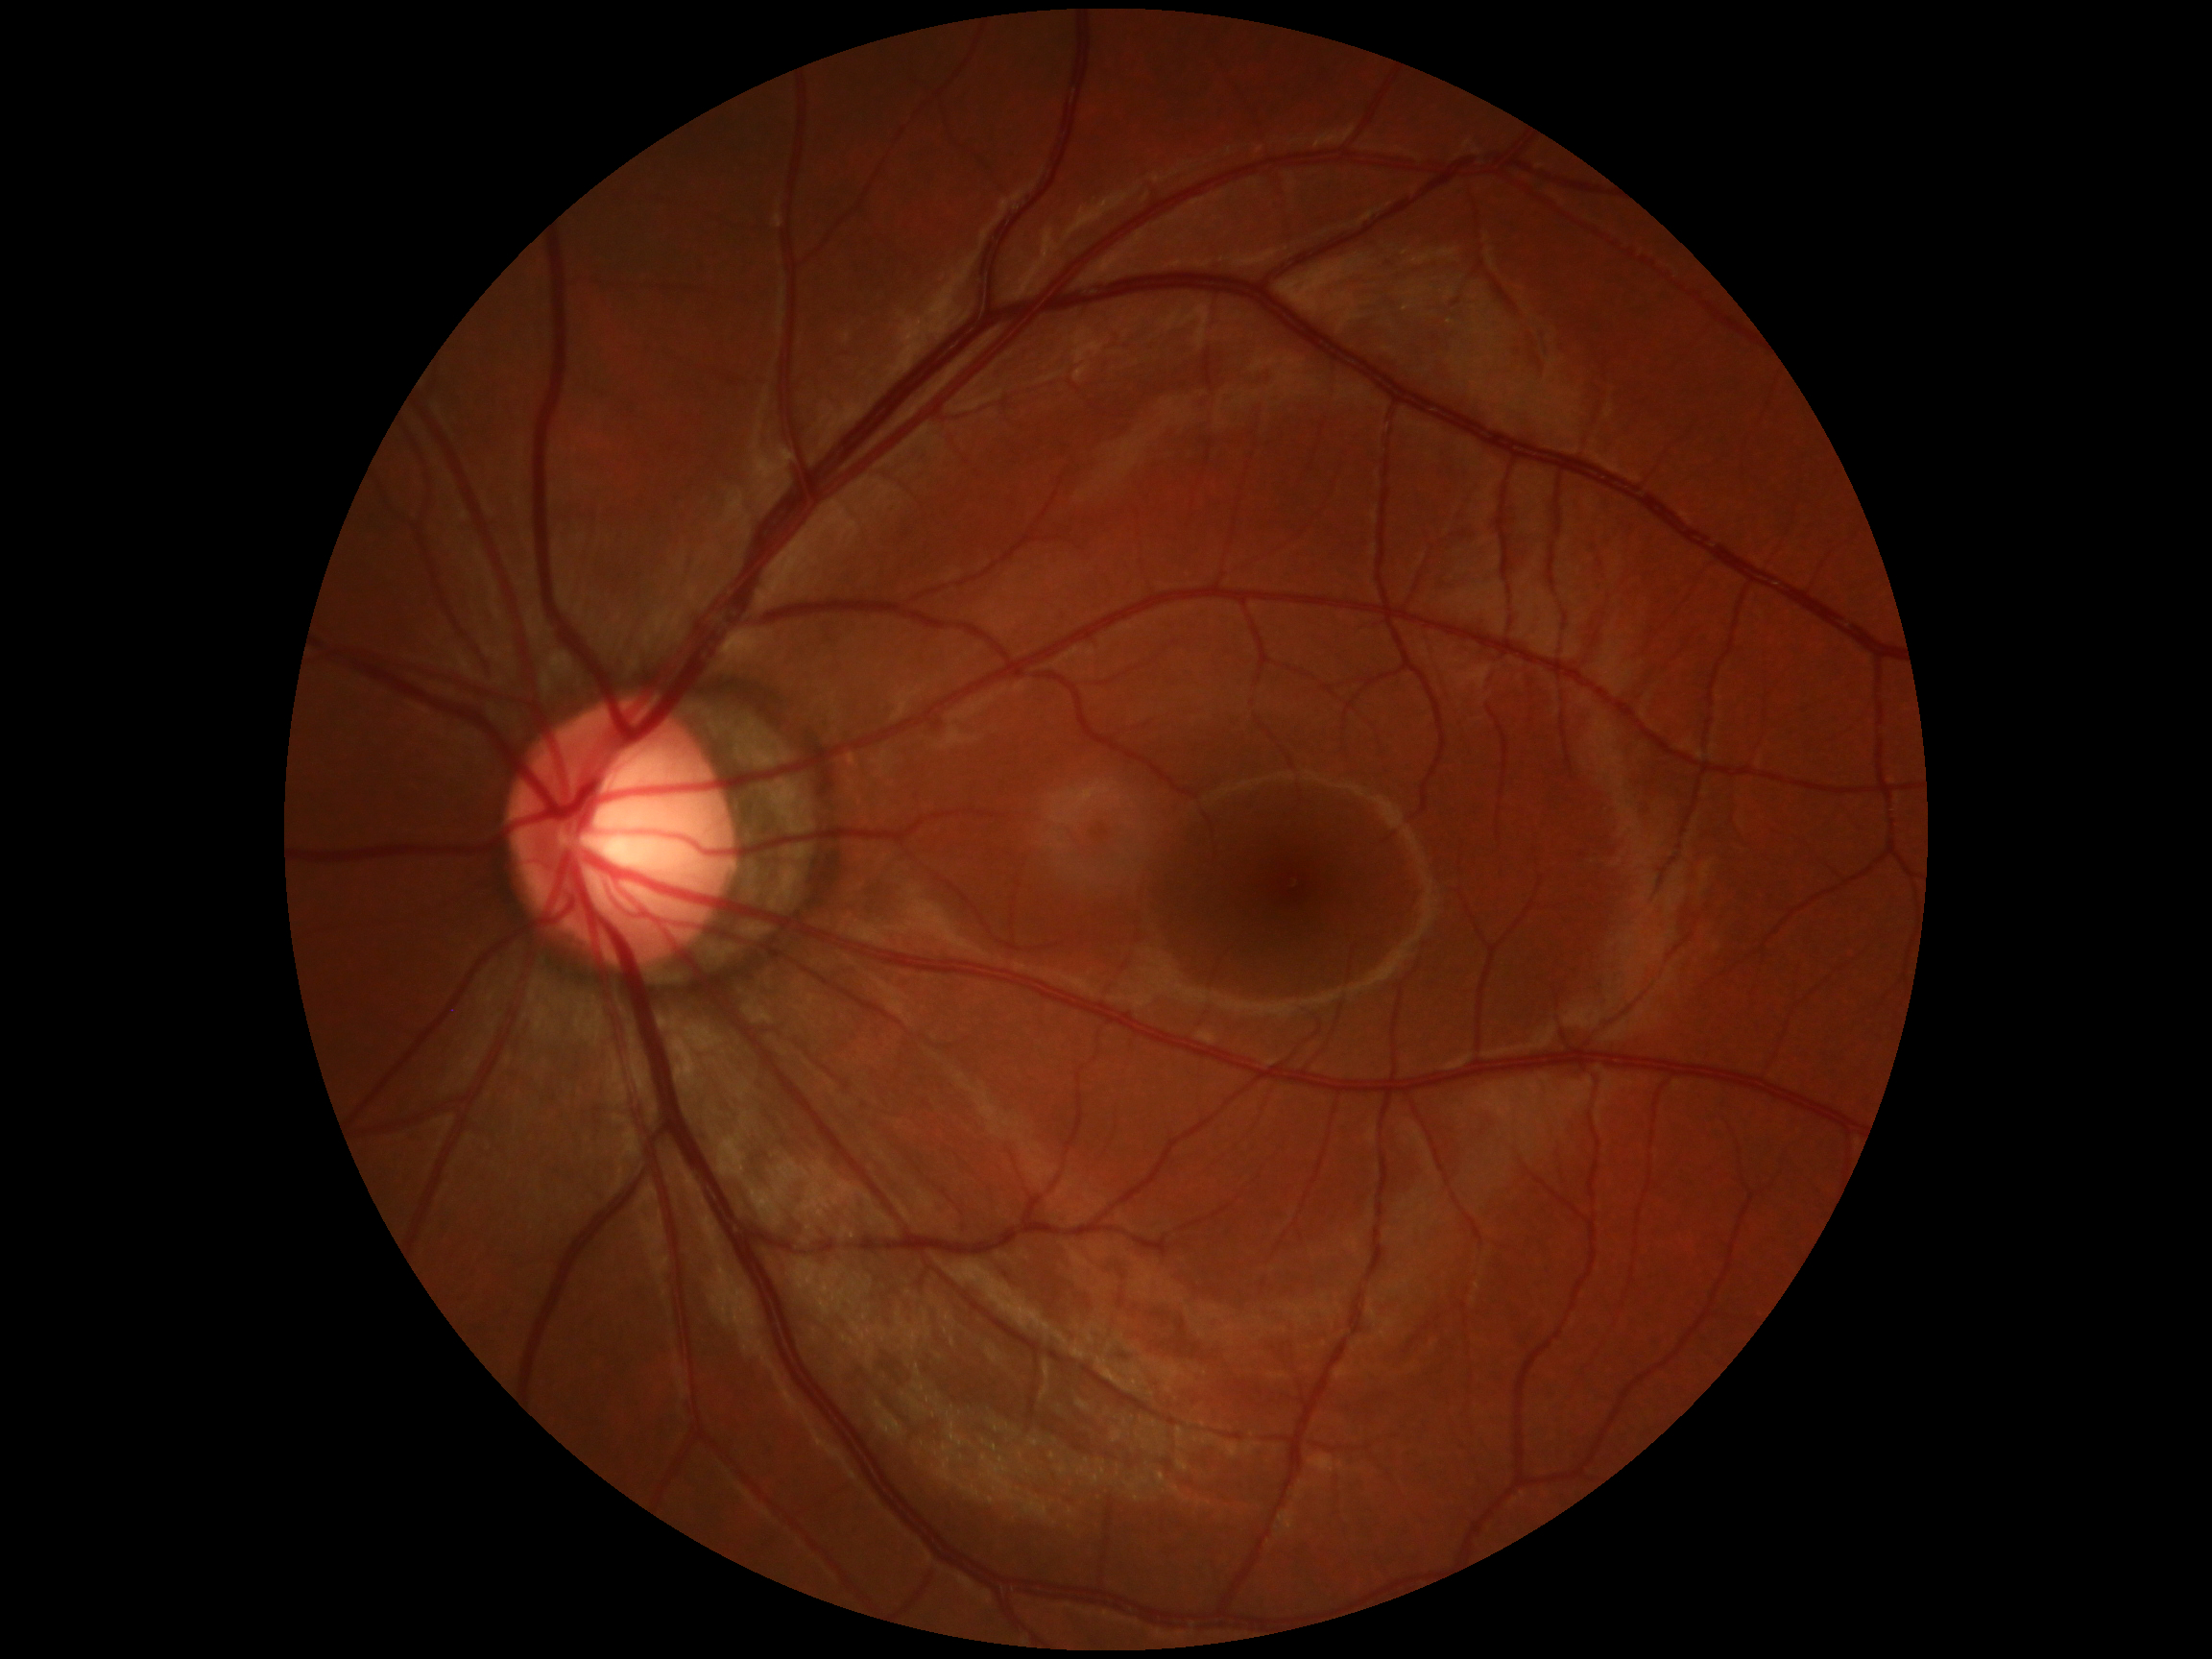
Diabetic retinopathy severity is no apparent retinopathy (grade 0) — no visible signs of diabetic retinopathy.